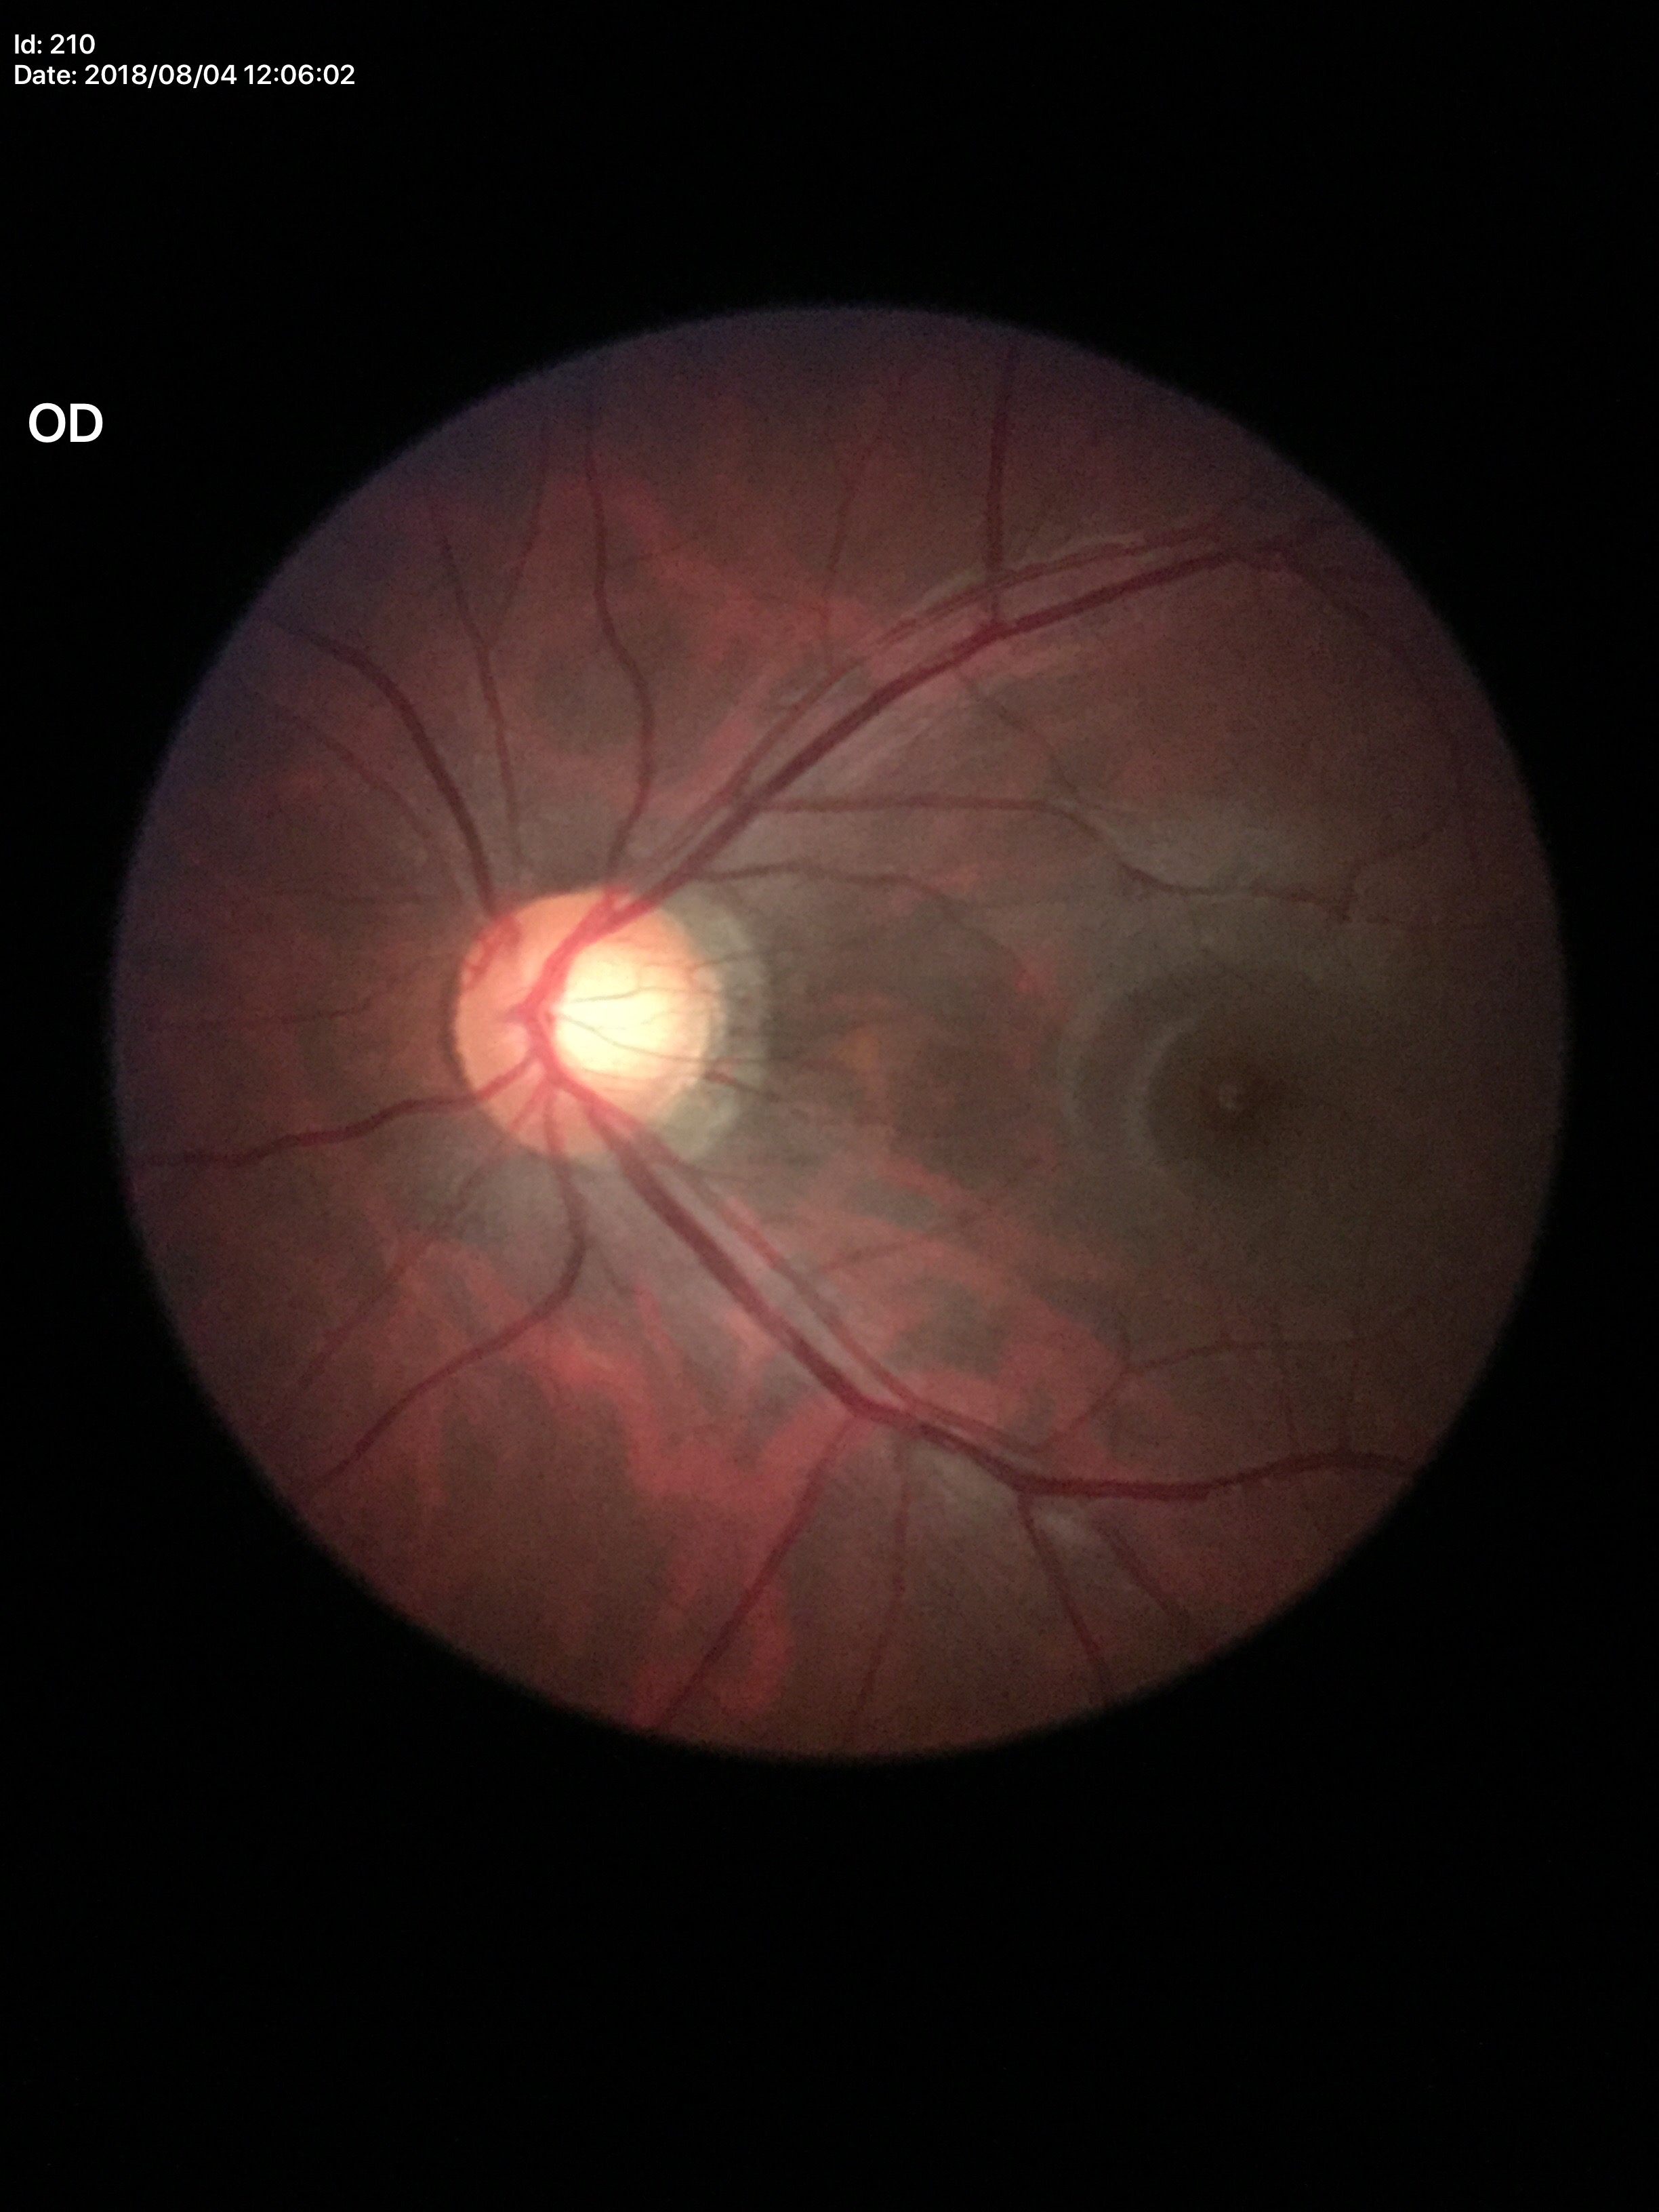
Glaucoma evaluation: suspicious findings.
Vertical cup-disc ratio of 0.66.
Horizontal cup-disc ratio is 0.69.